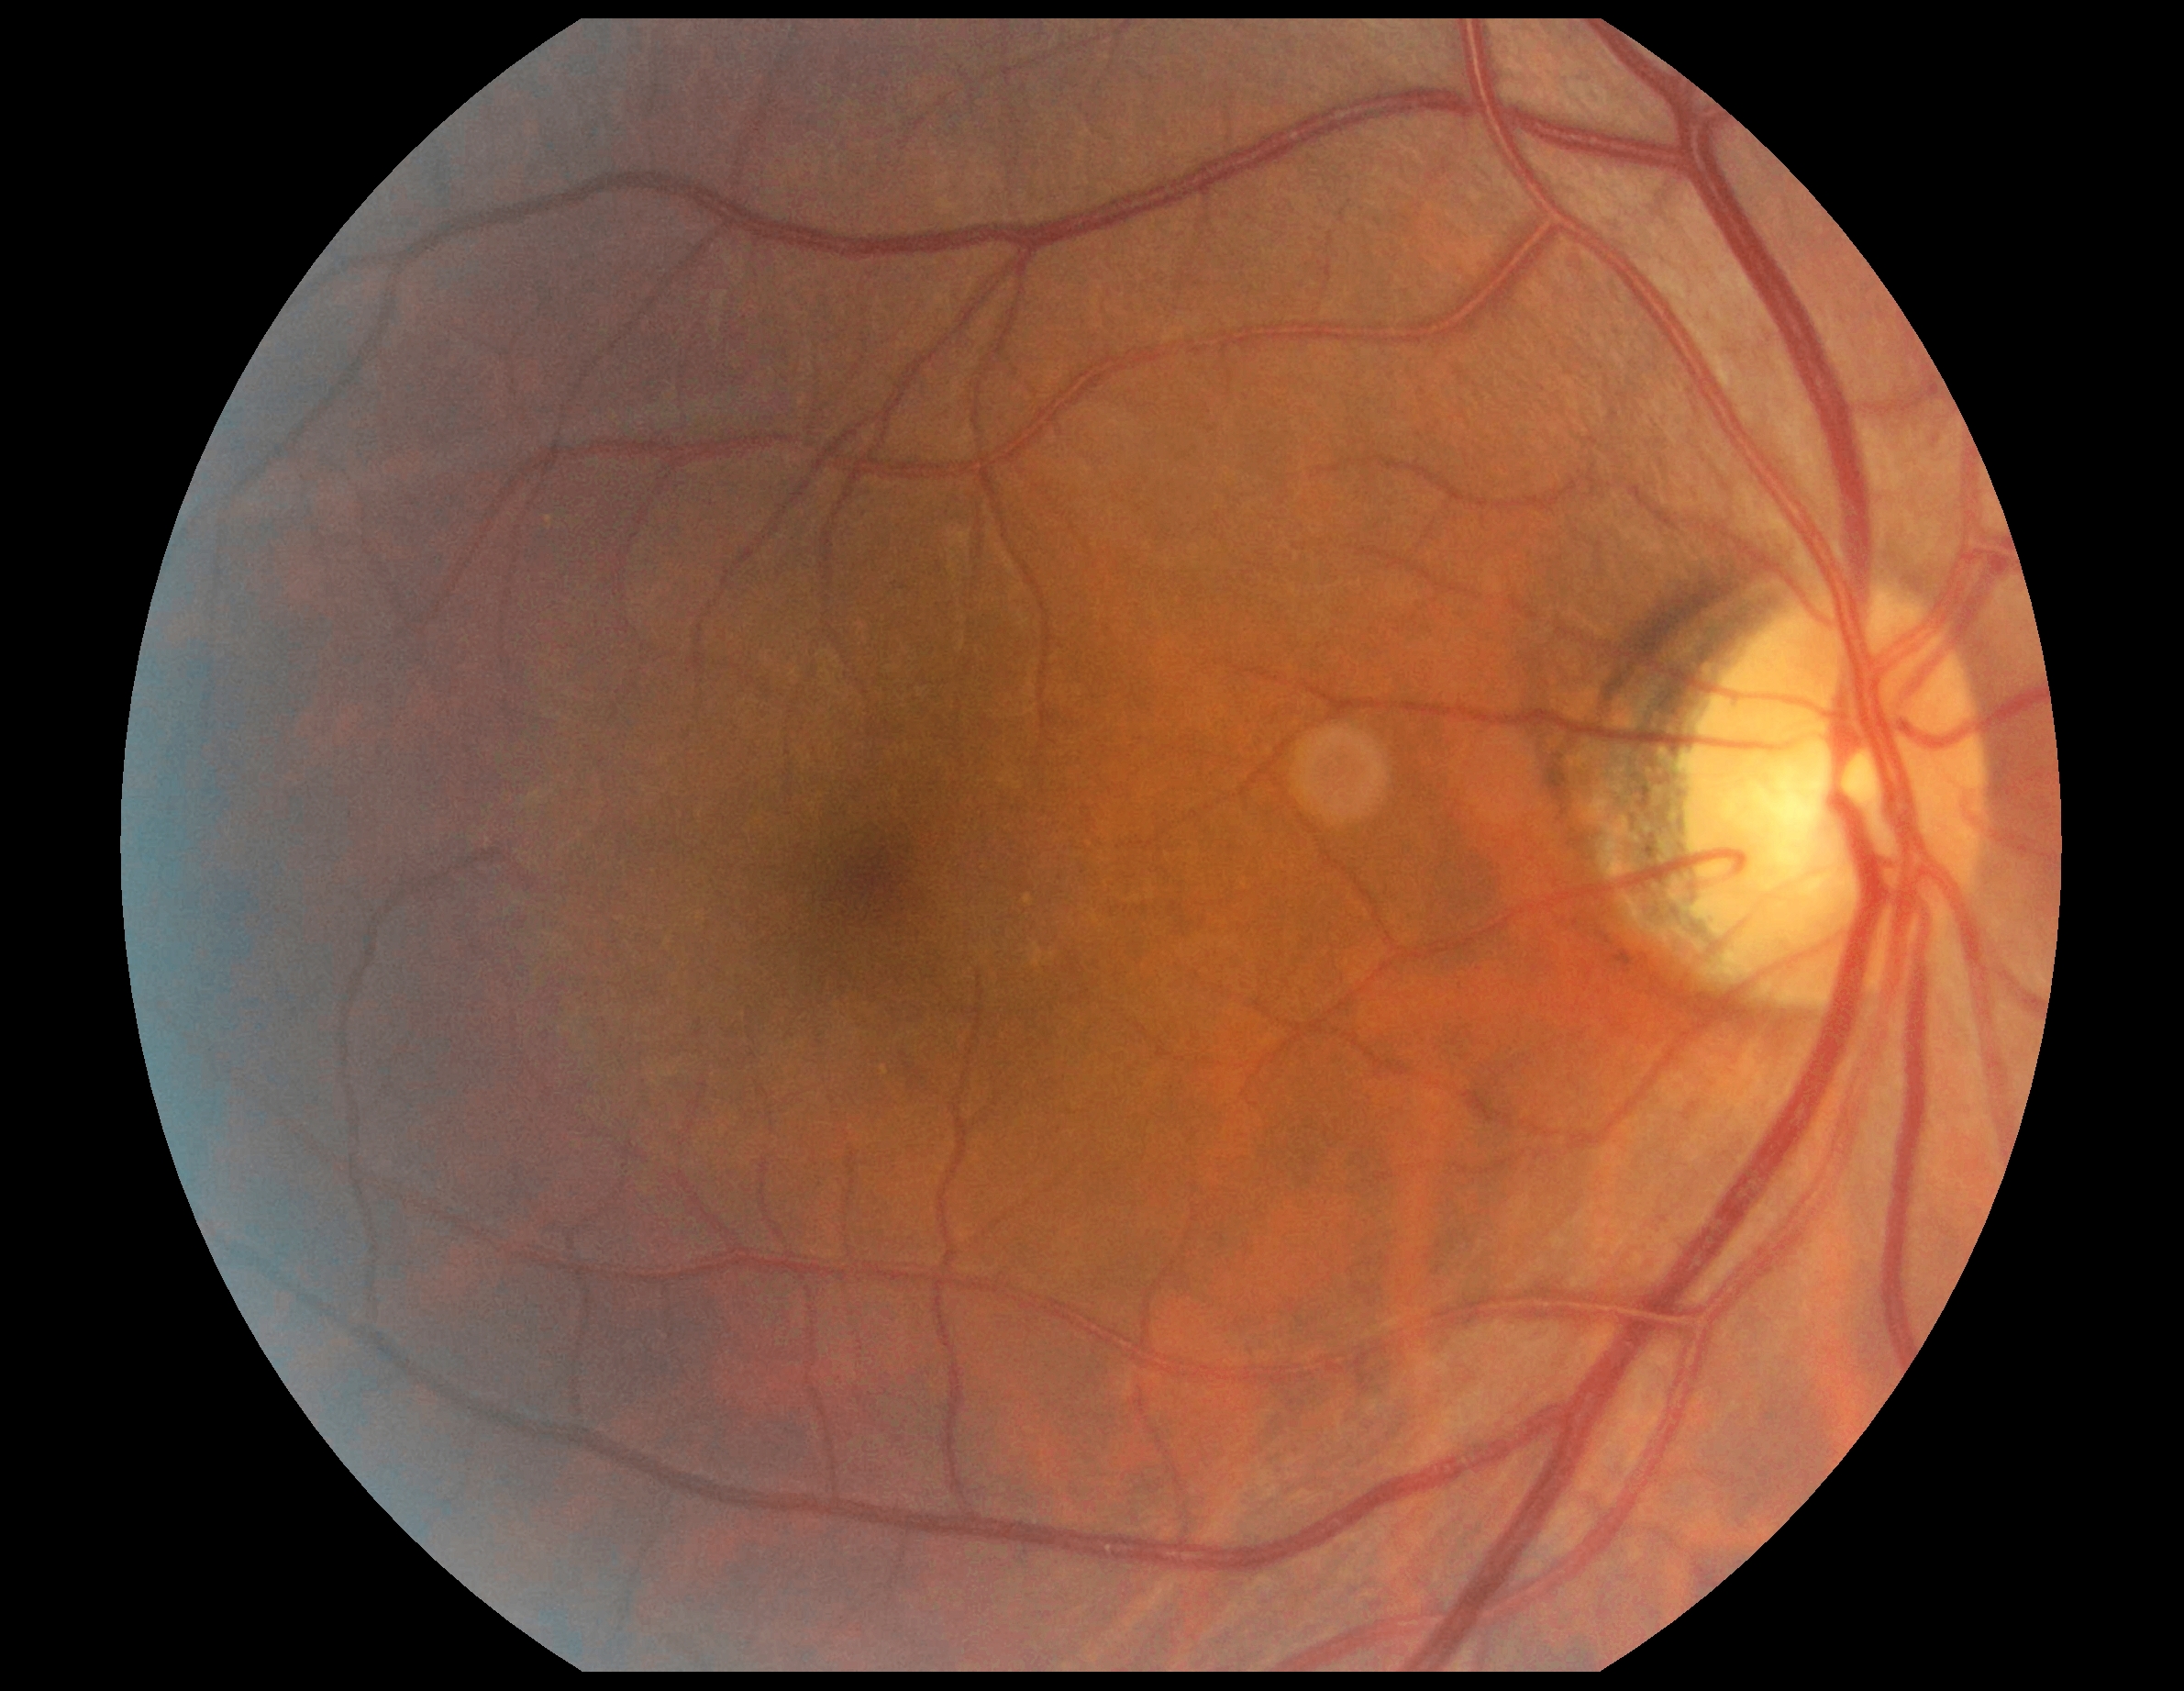

{
  "dr_impression": "negative for DR",
  "dr_grade": "no apparent diabetic retinopathy (0)"
}